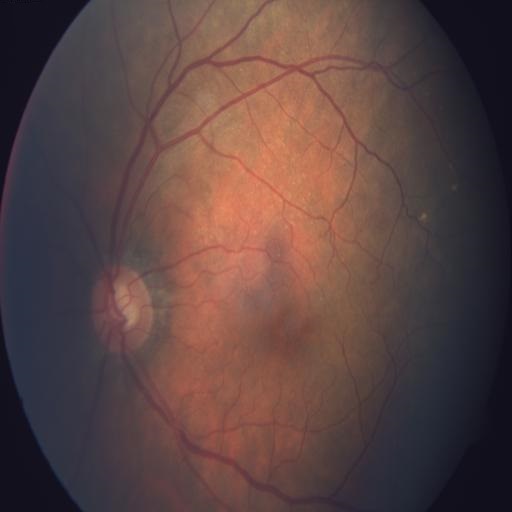

Diagnoses: optic disc cupping (ODC).